130° field of view (Clarity RetCam 3); infant wide-field retinal image.
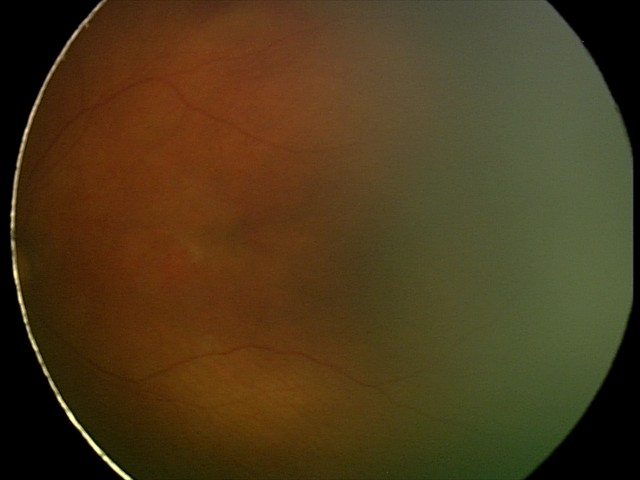

Q: What was the screening finding?
A: normal fundus examination